CFP.
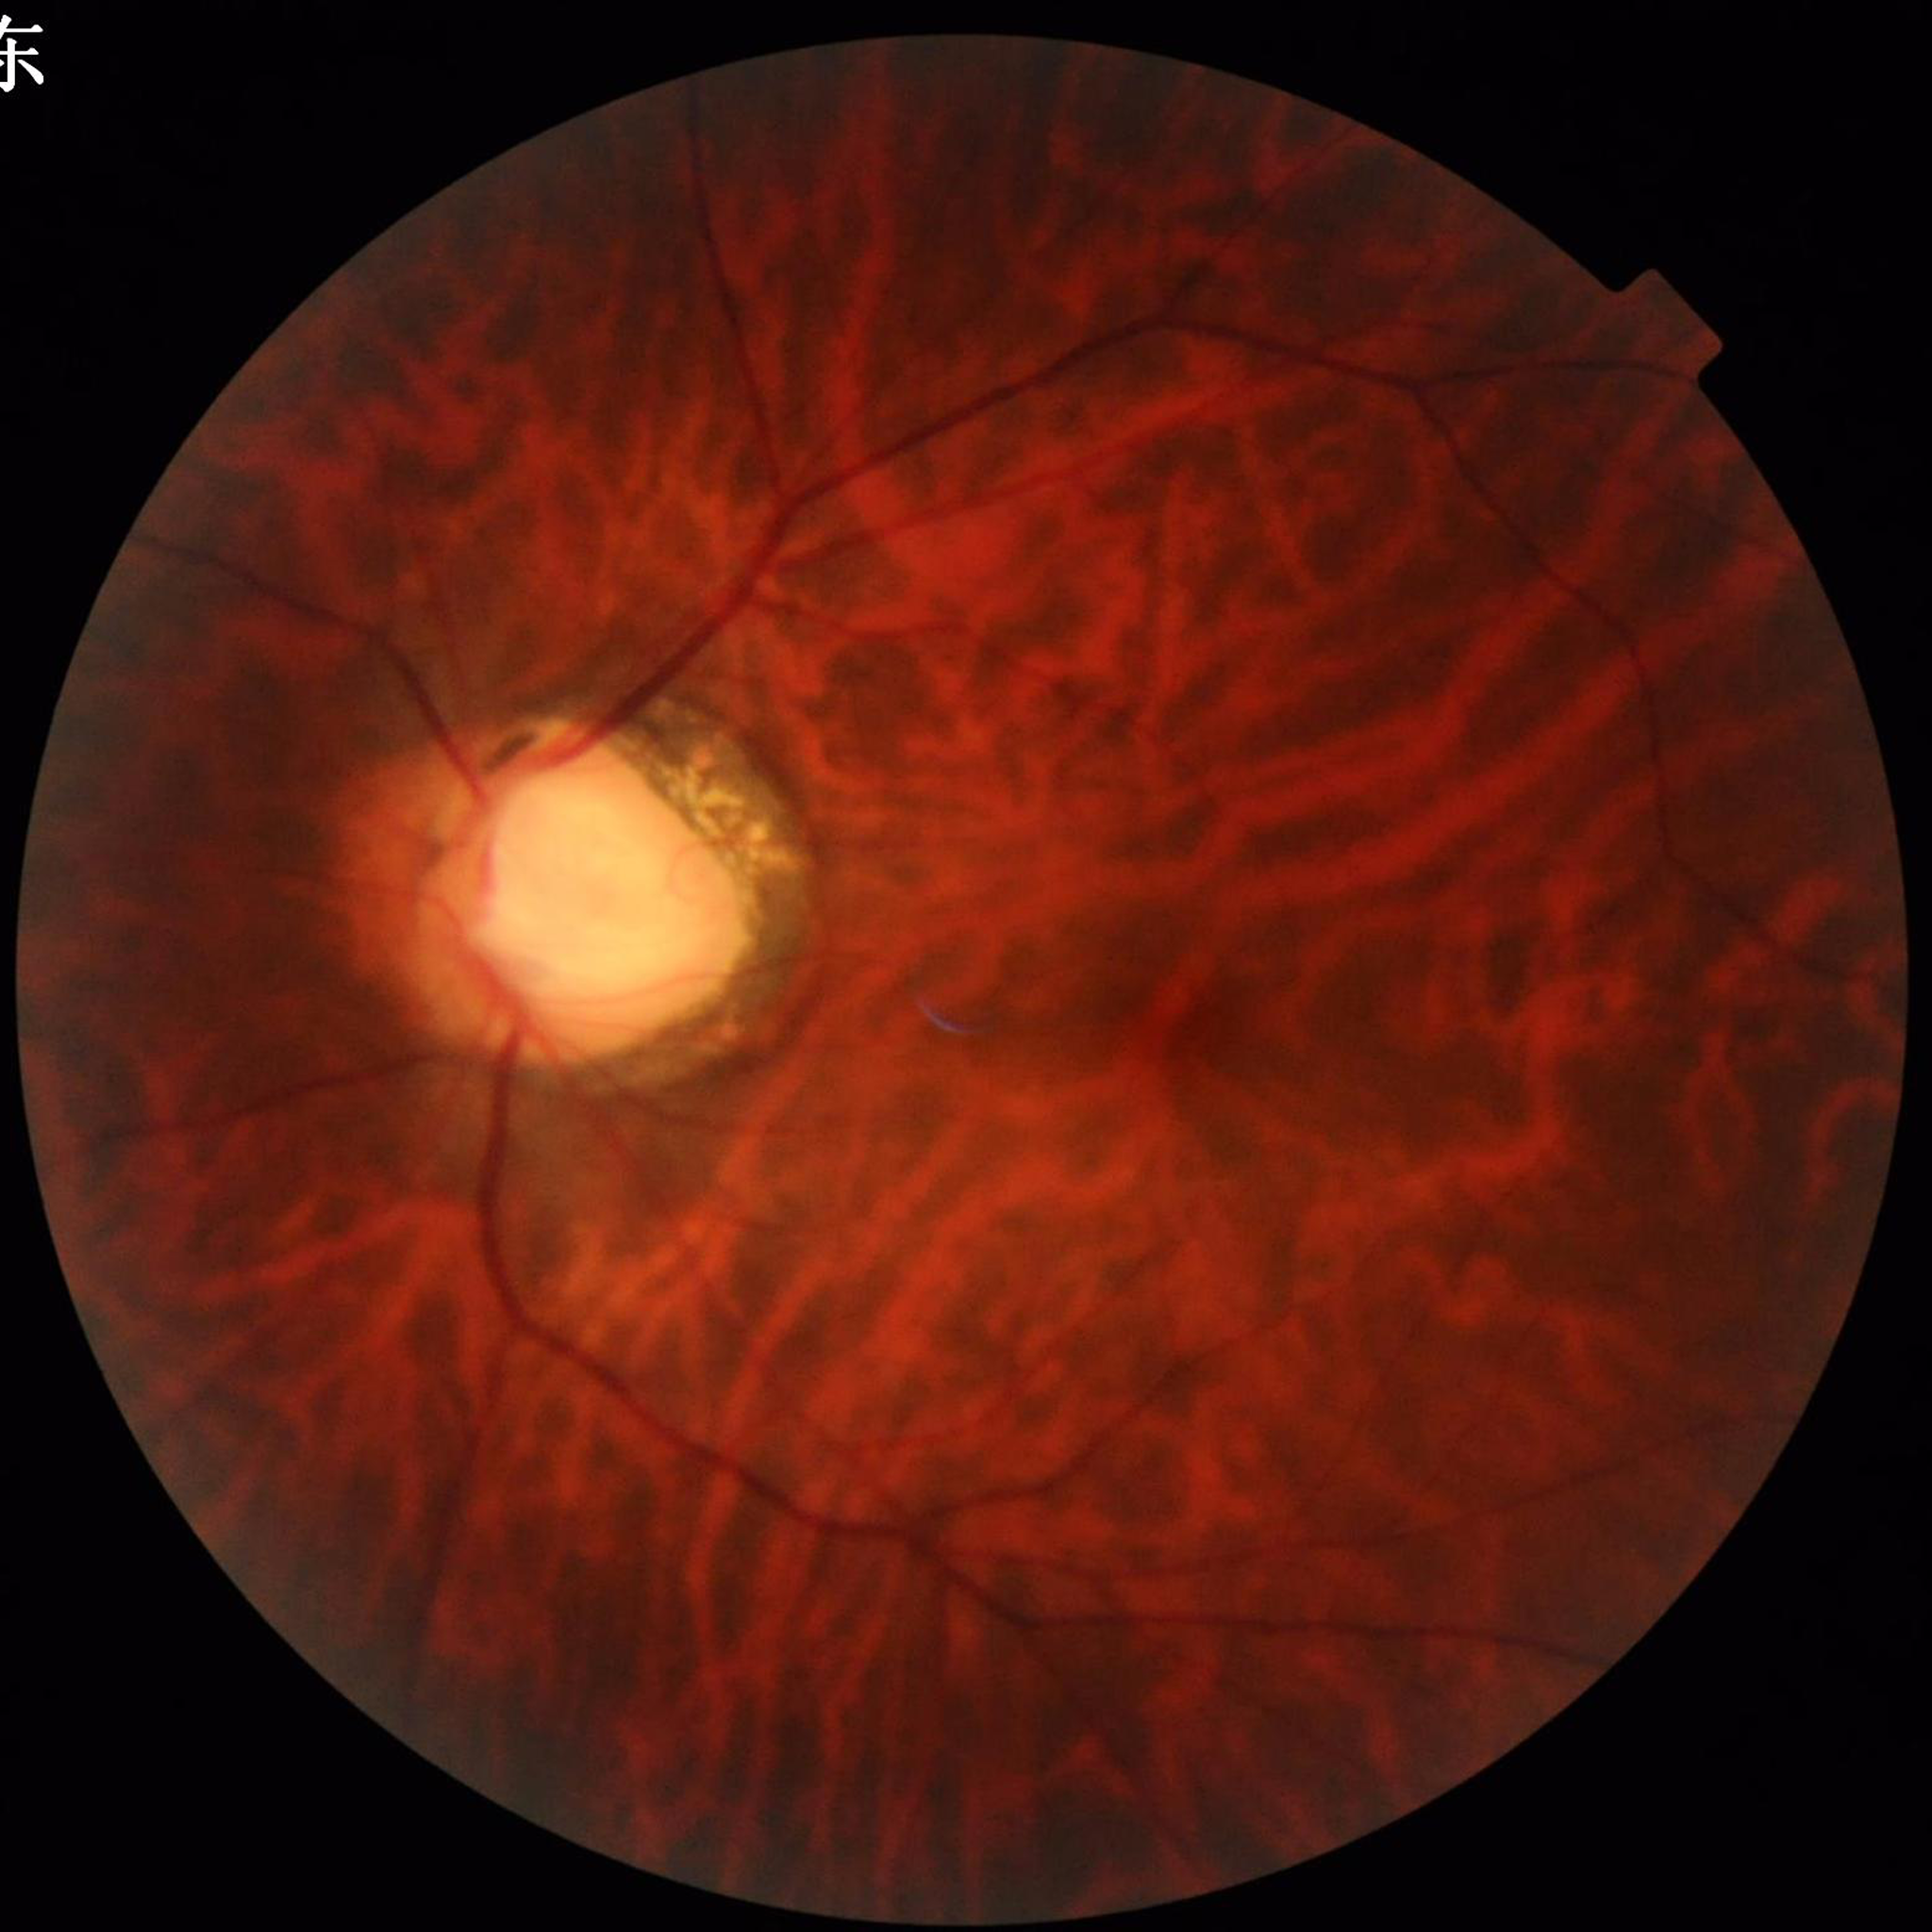

Quality: good. Patient diagnosed with glaucoma.